Color fundus photograph: 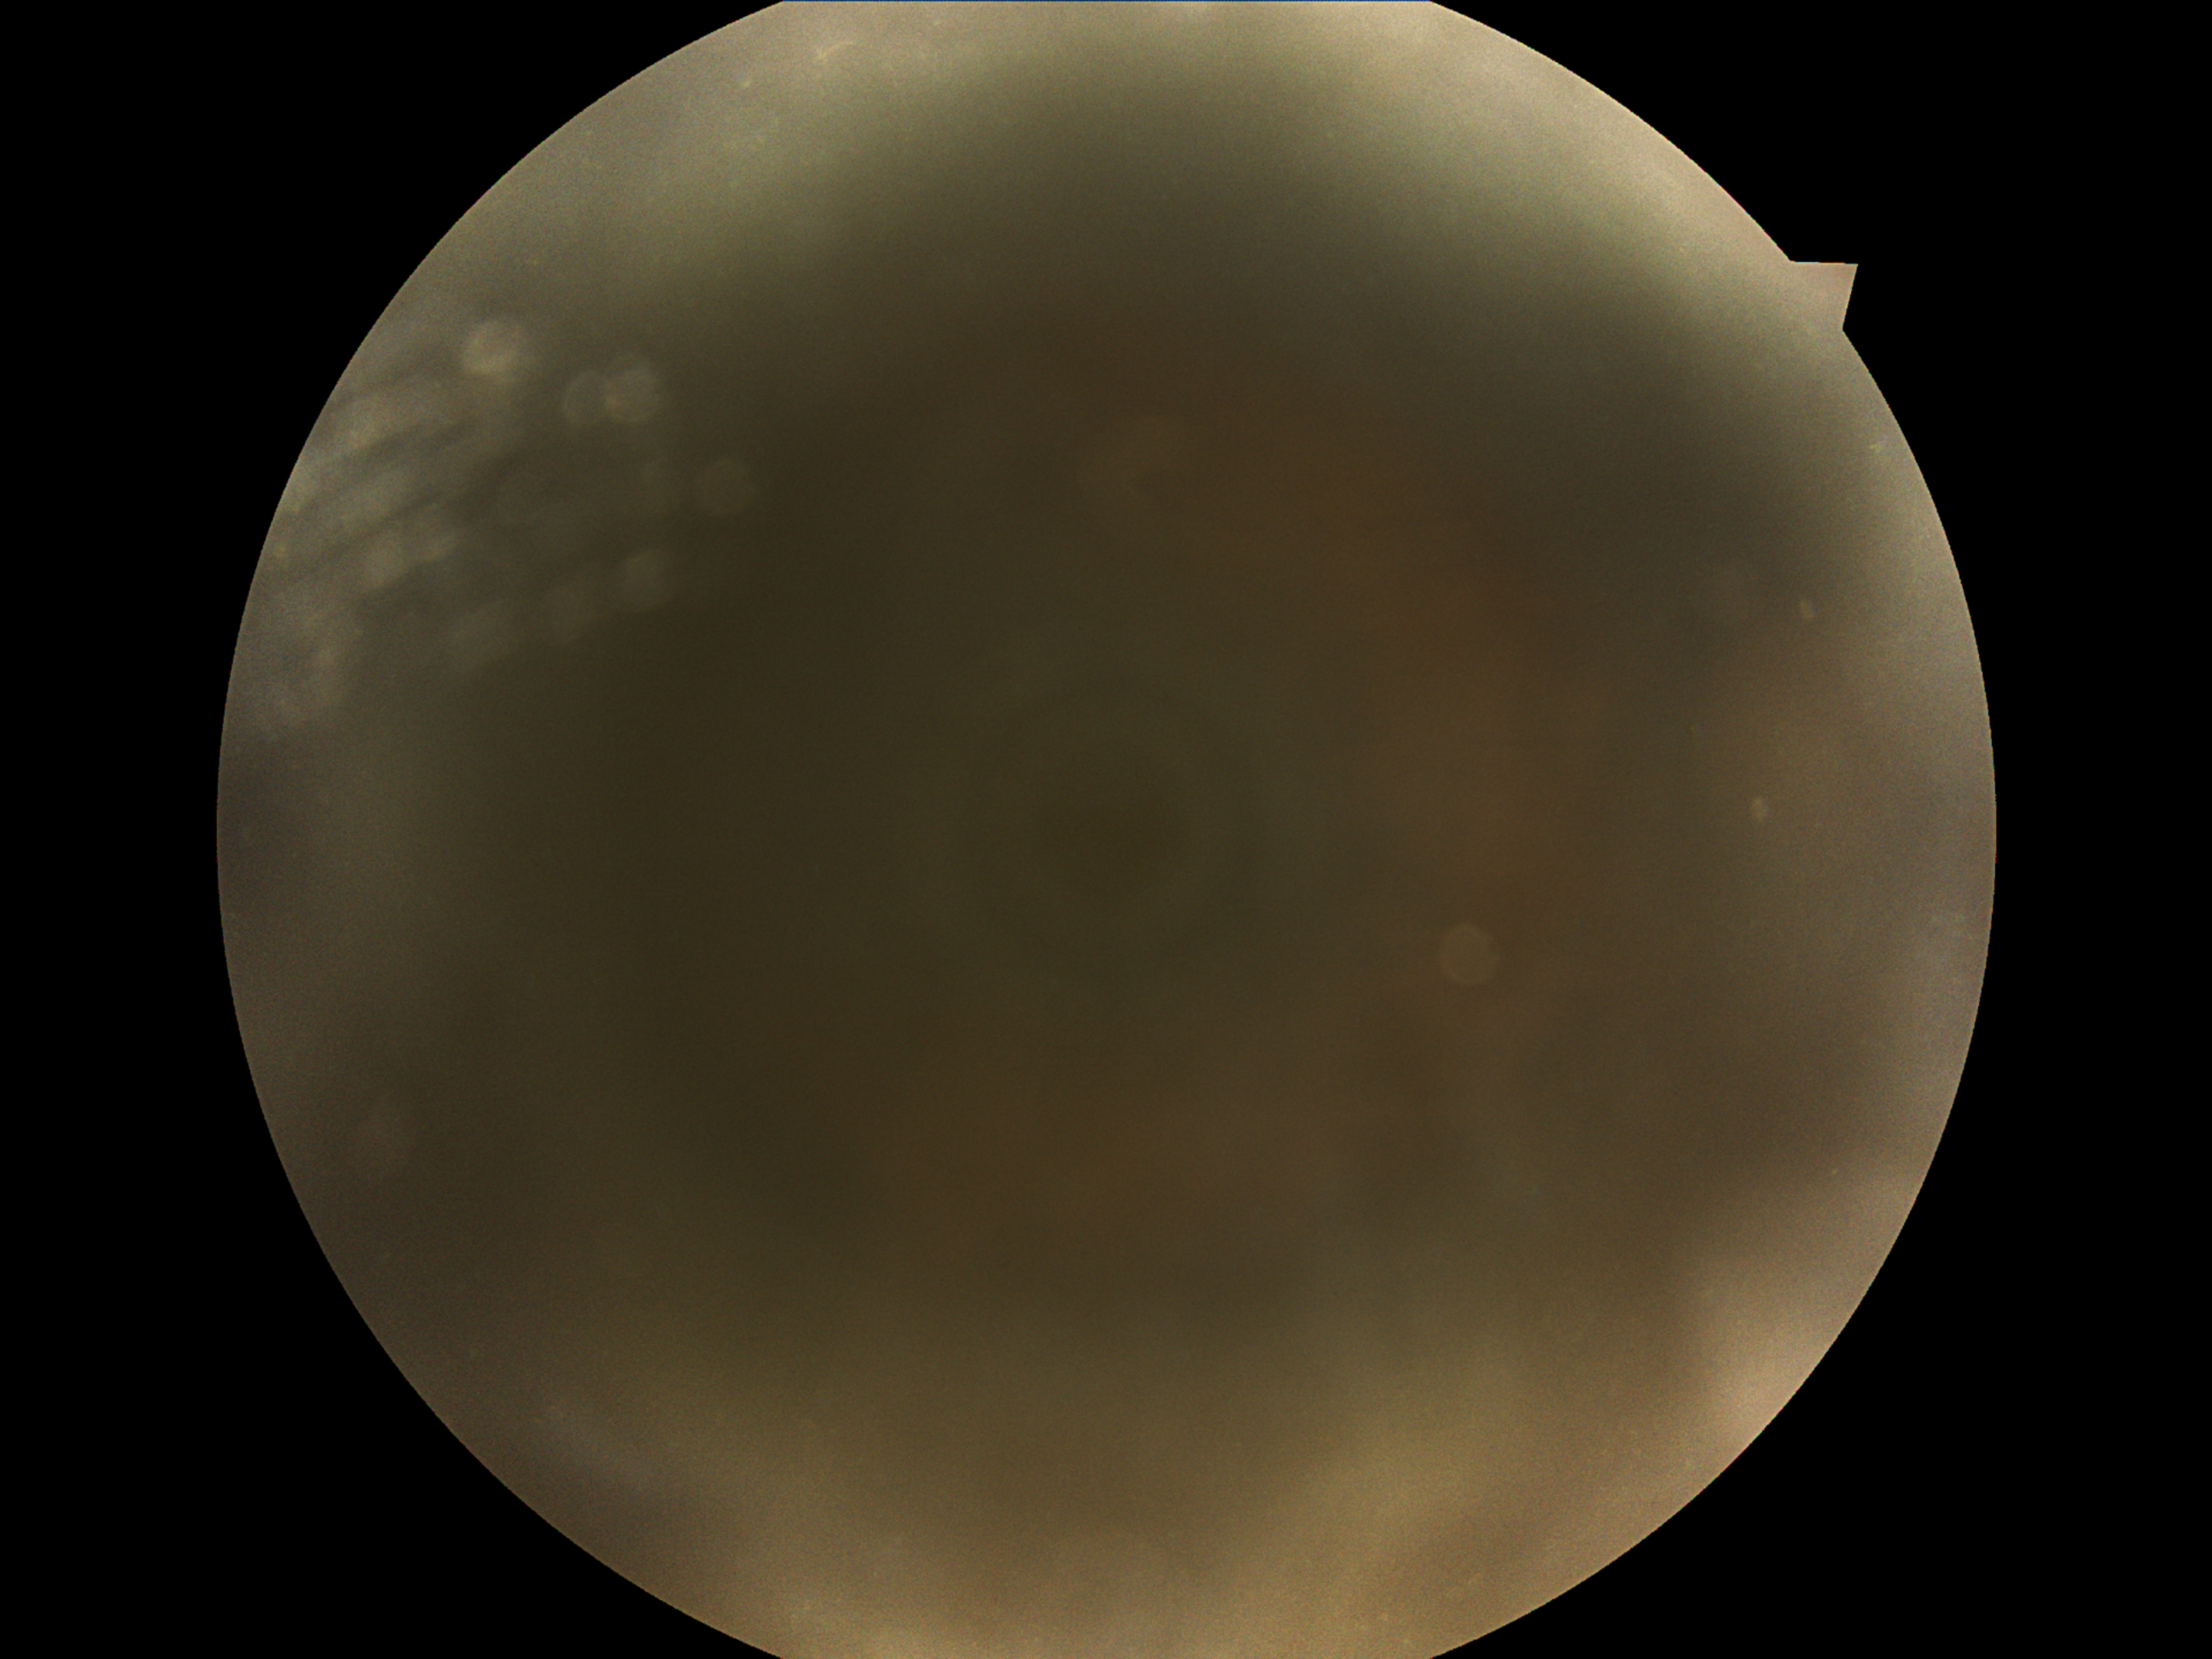

DR severity: ungradable due to poor image quality.